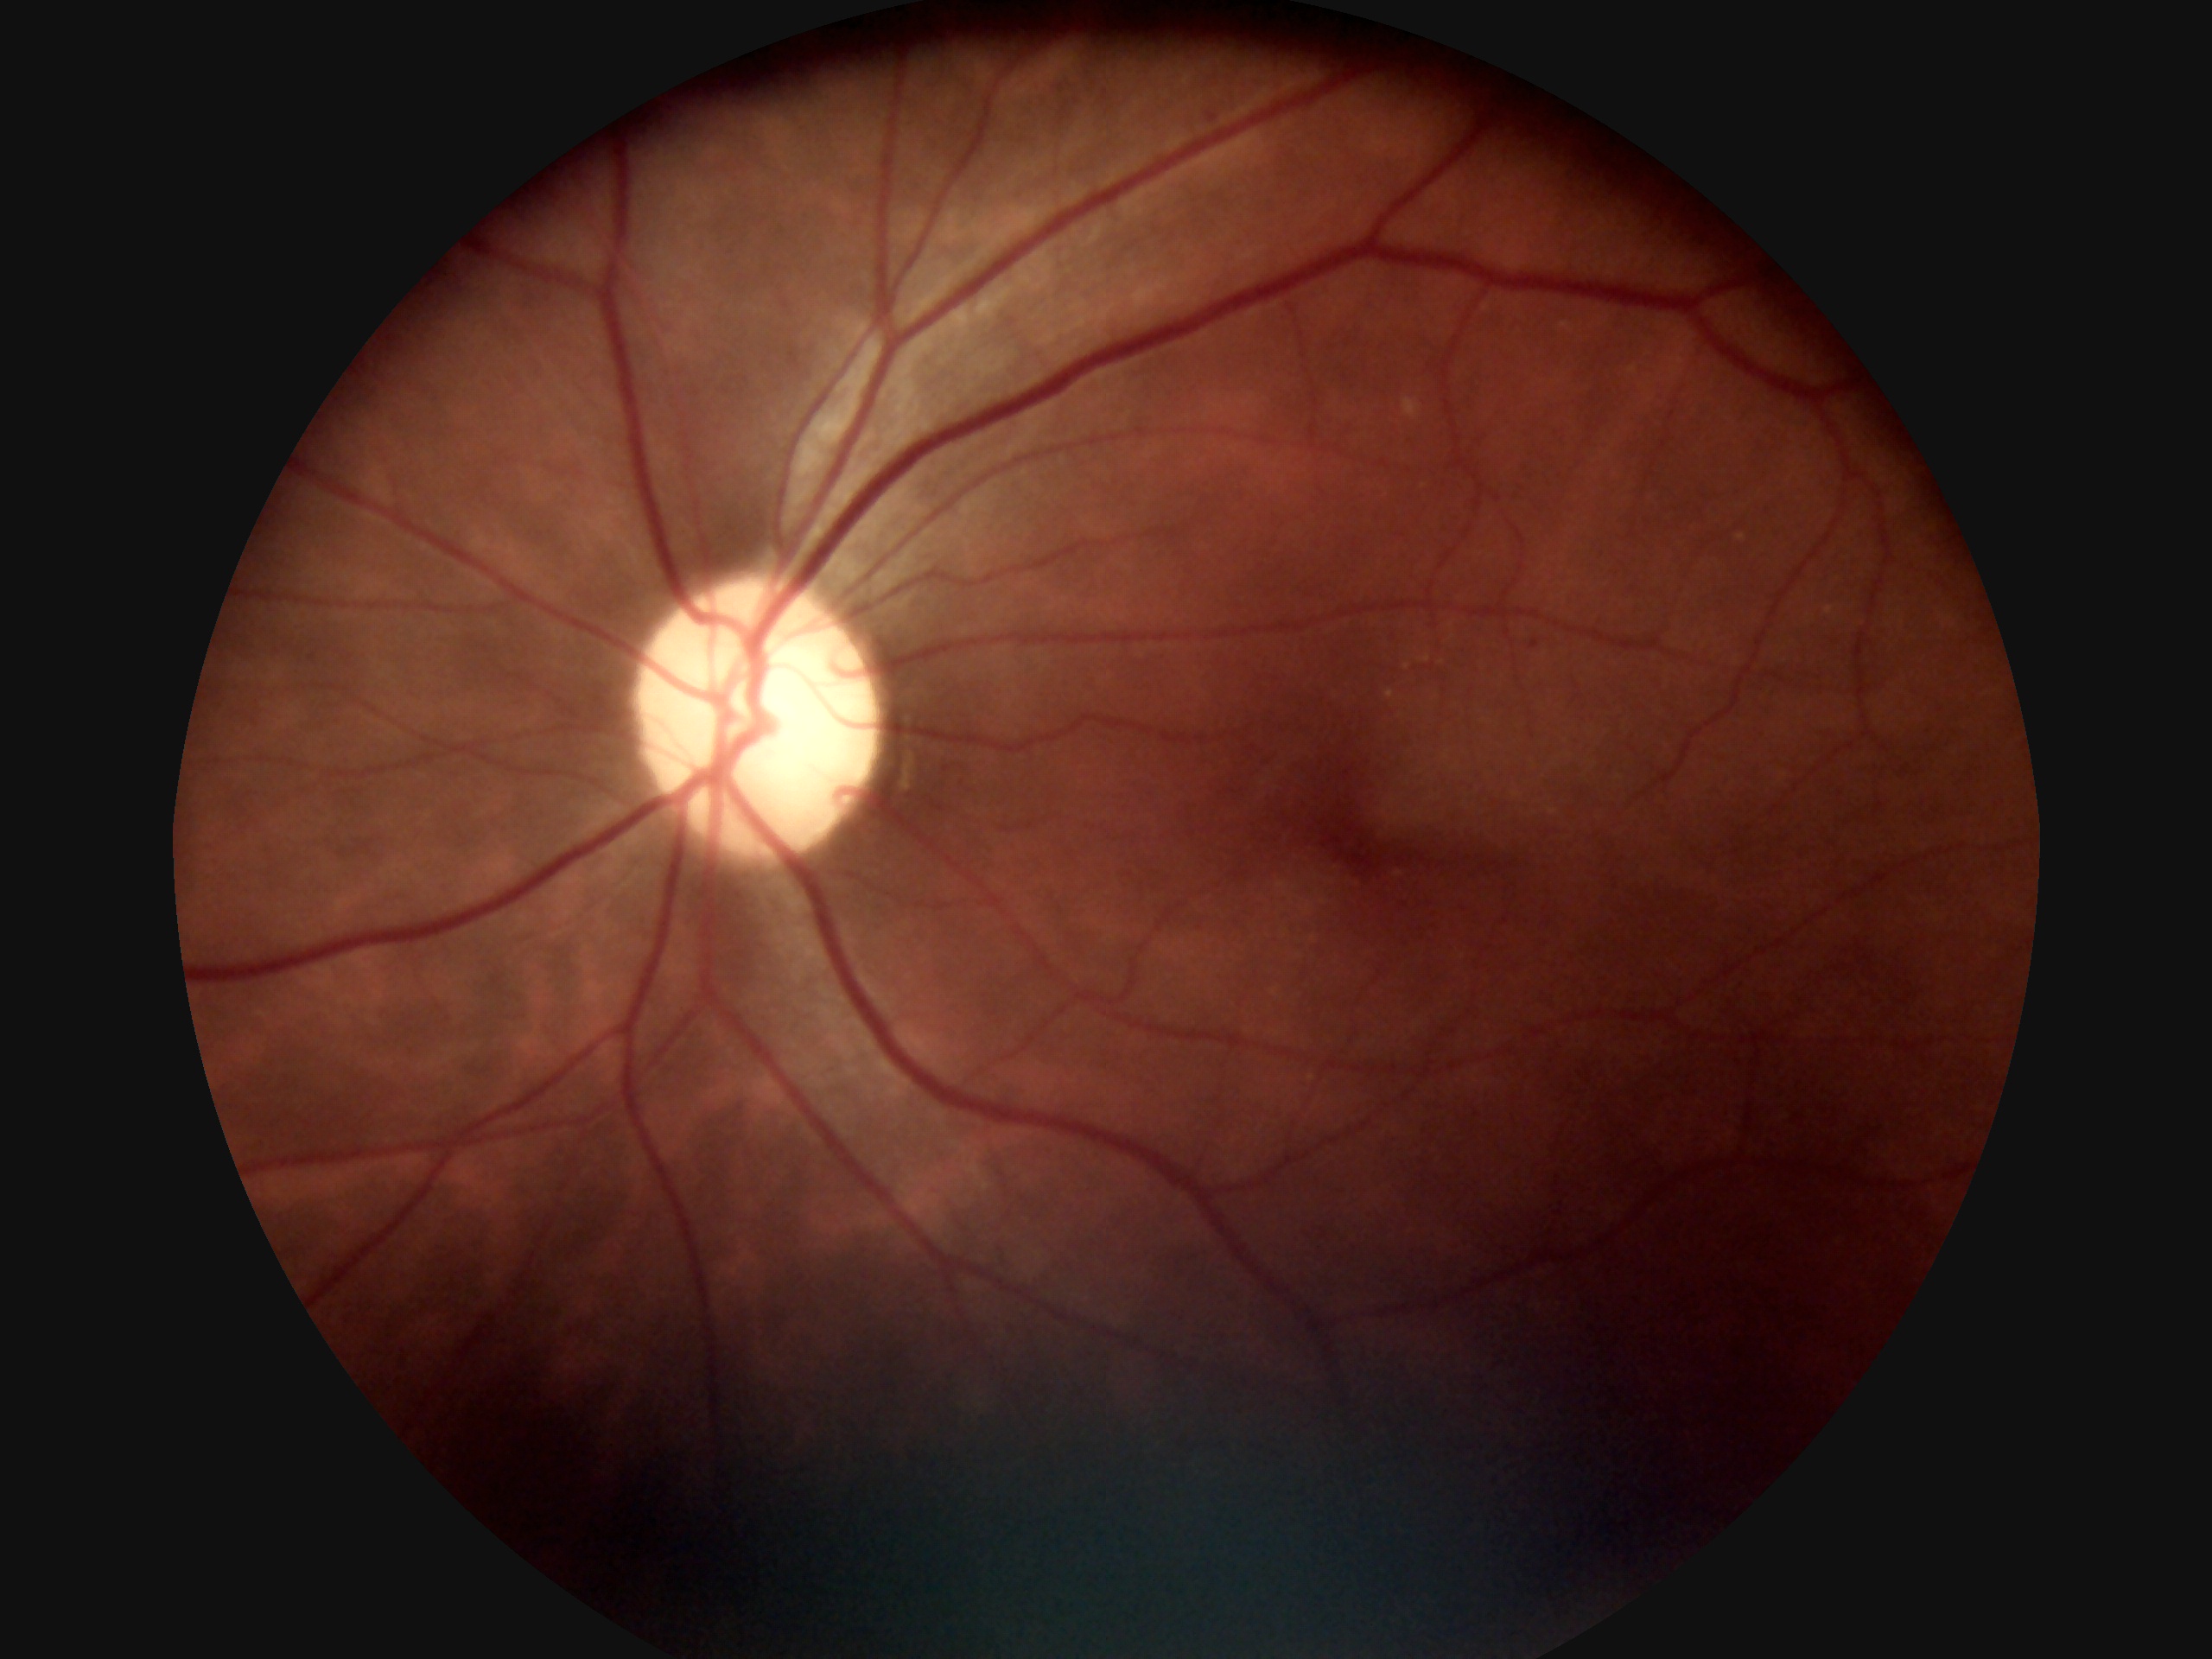 DR stage is mild non-proliferative diabetic retinopathy (grade 1).